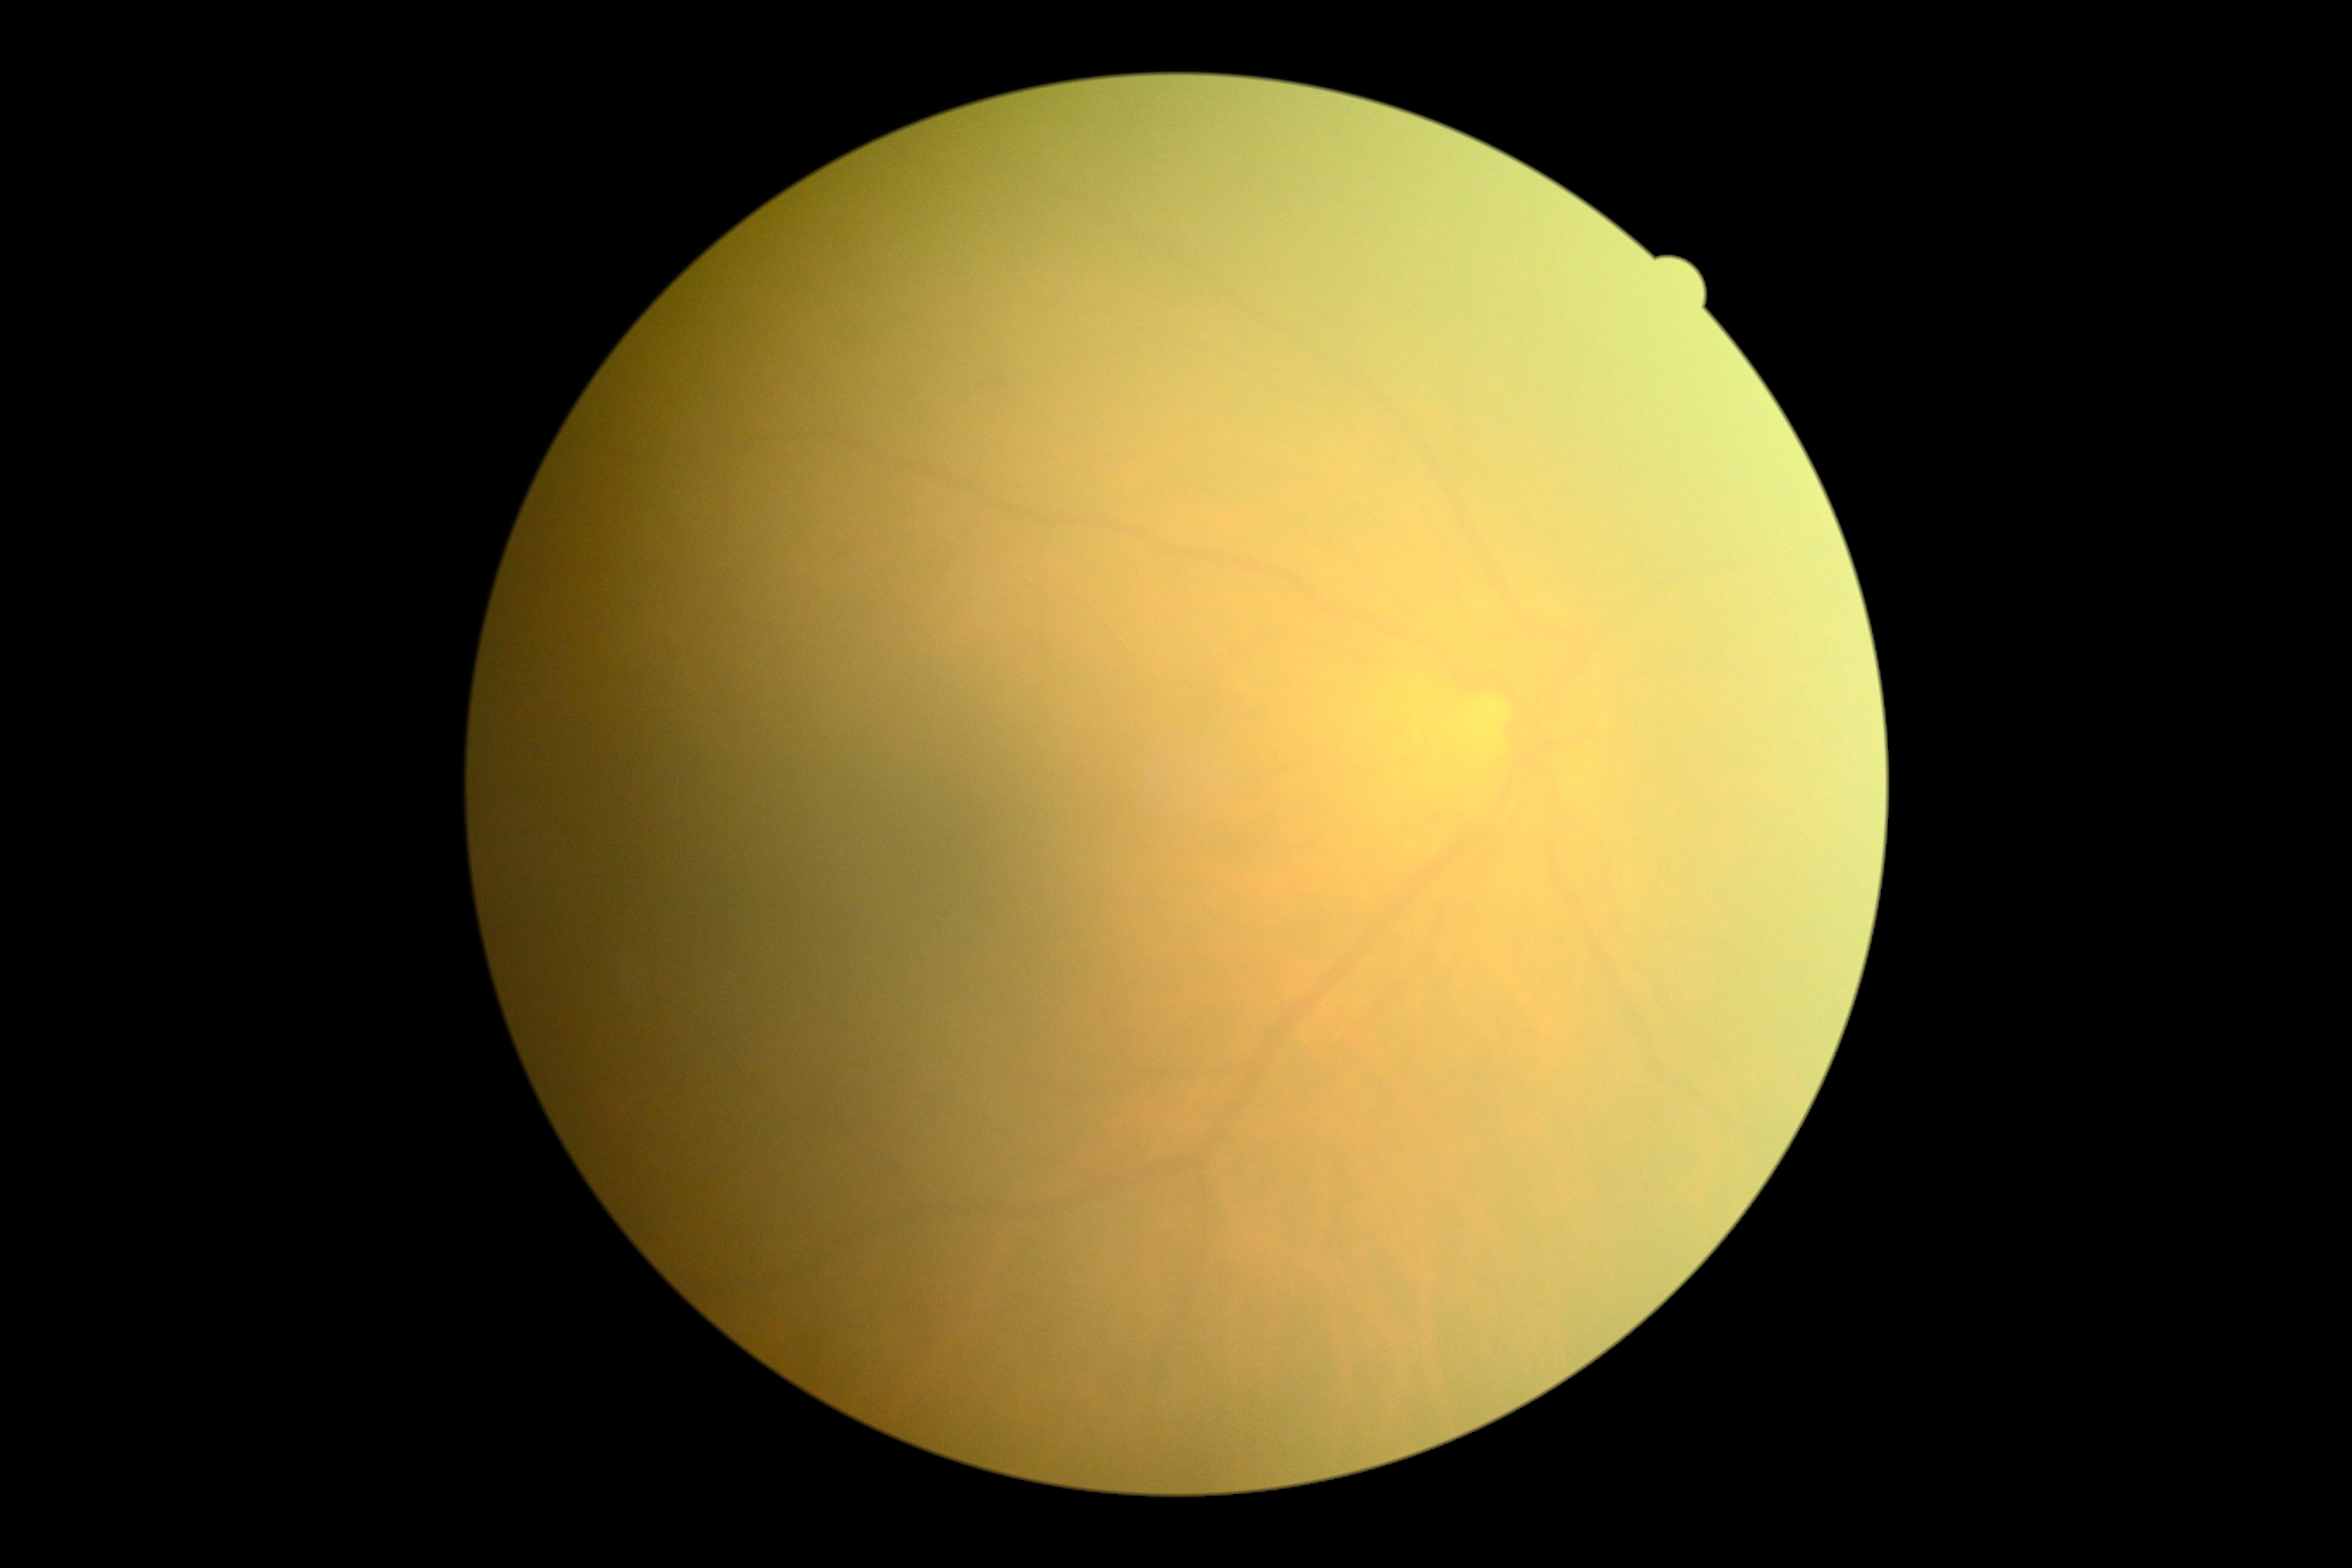
quality: insufficient
dr_grade: ungradable